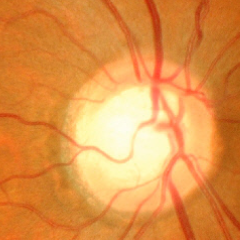 Showing advanced glaucomatous optic neuropathy. Diagnostic criteria: near-total cupping of the optic nerve head, with or without severe visual field loss within the central 10 degrees of fixation.